Refractive error: sphere -0.5 D, cylinder -2 D, axis 100°. Captured on a Topcon TRC-NW400 fundus camera. 2212x1661px. Patient age: 89 years. Axial length: 24.33 mm. Optic disc at the center of the field. Pachymetry 575 µm:
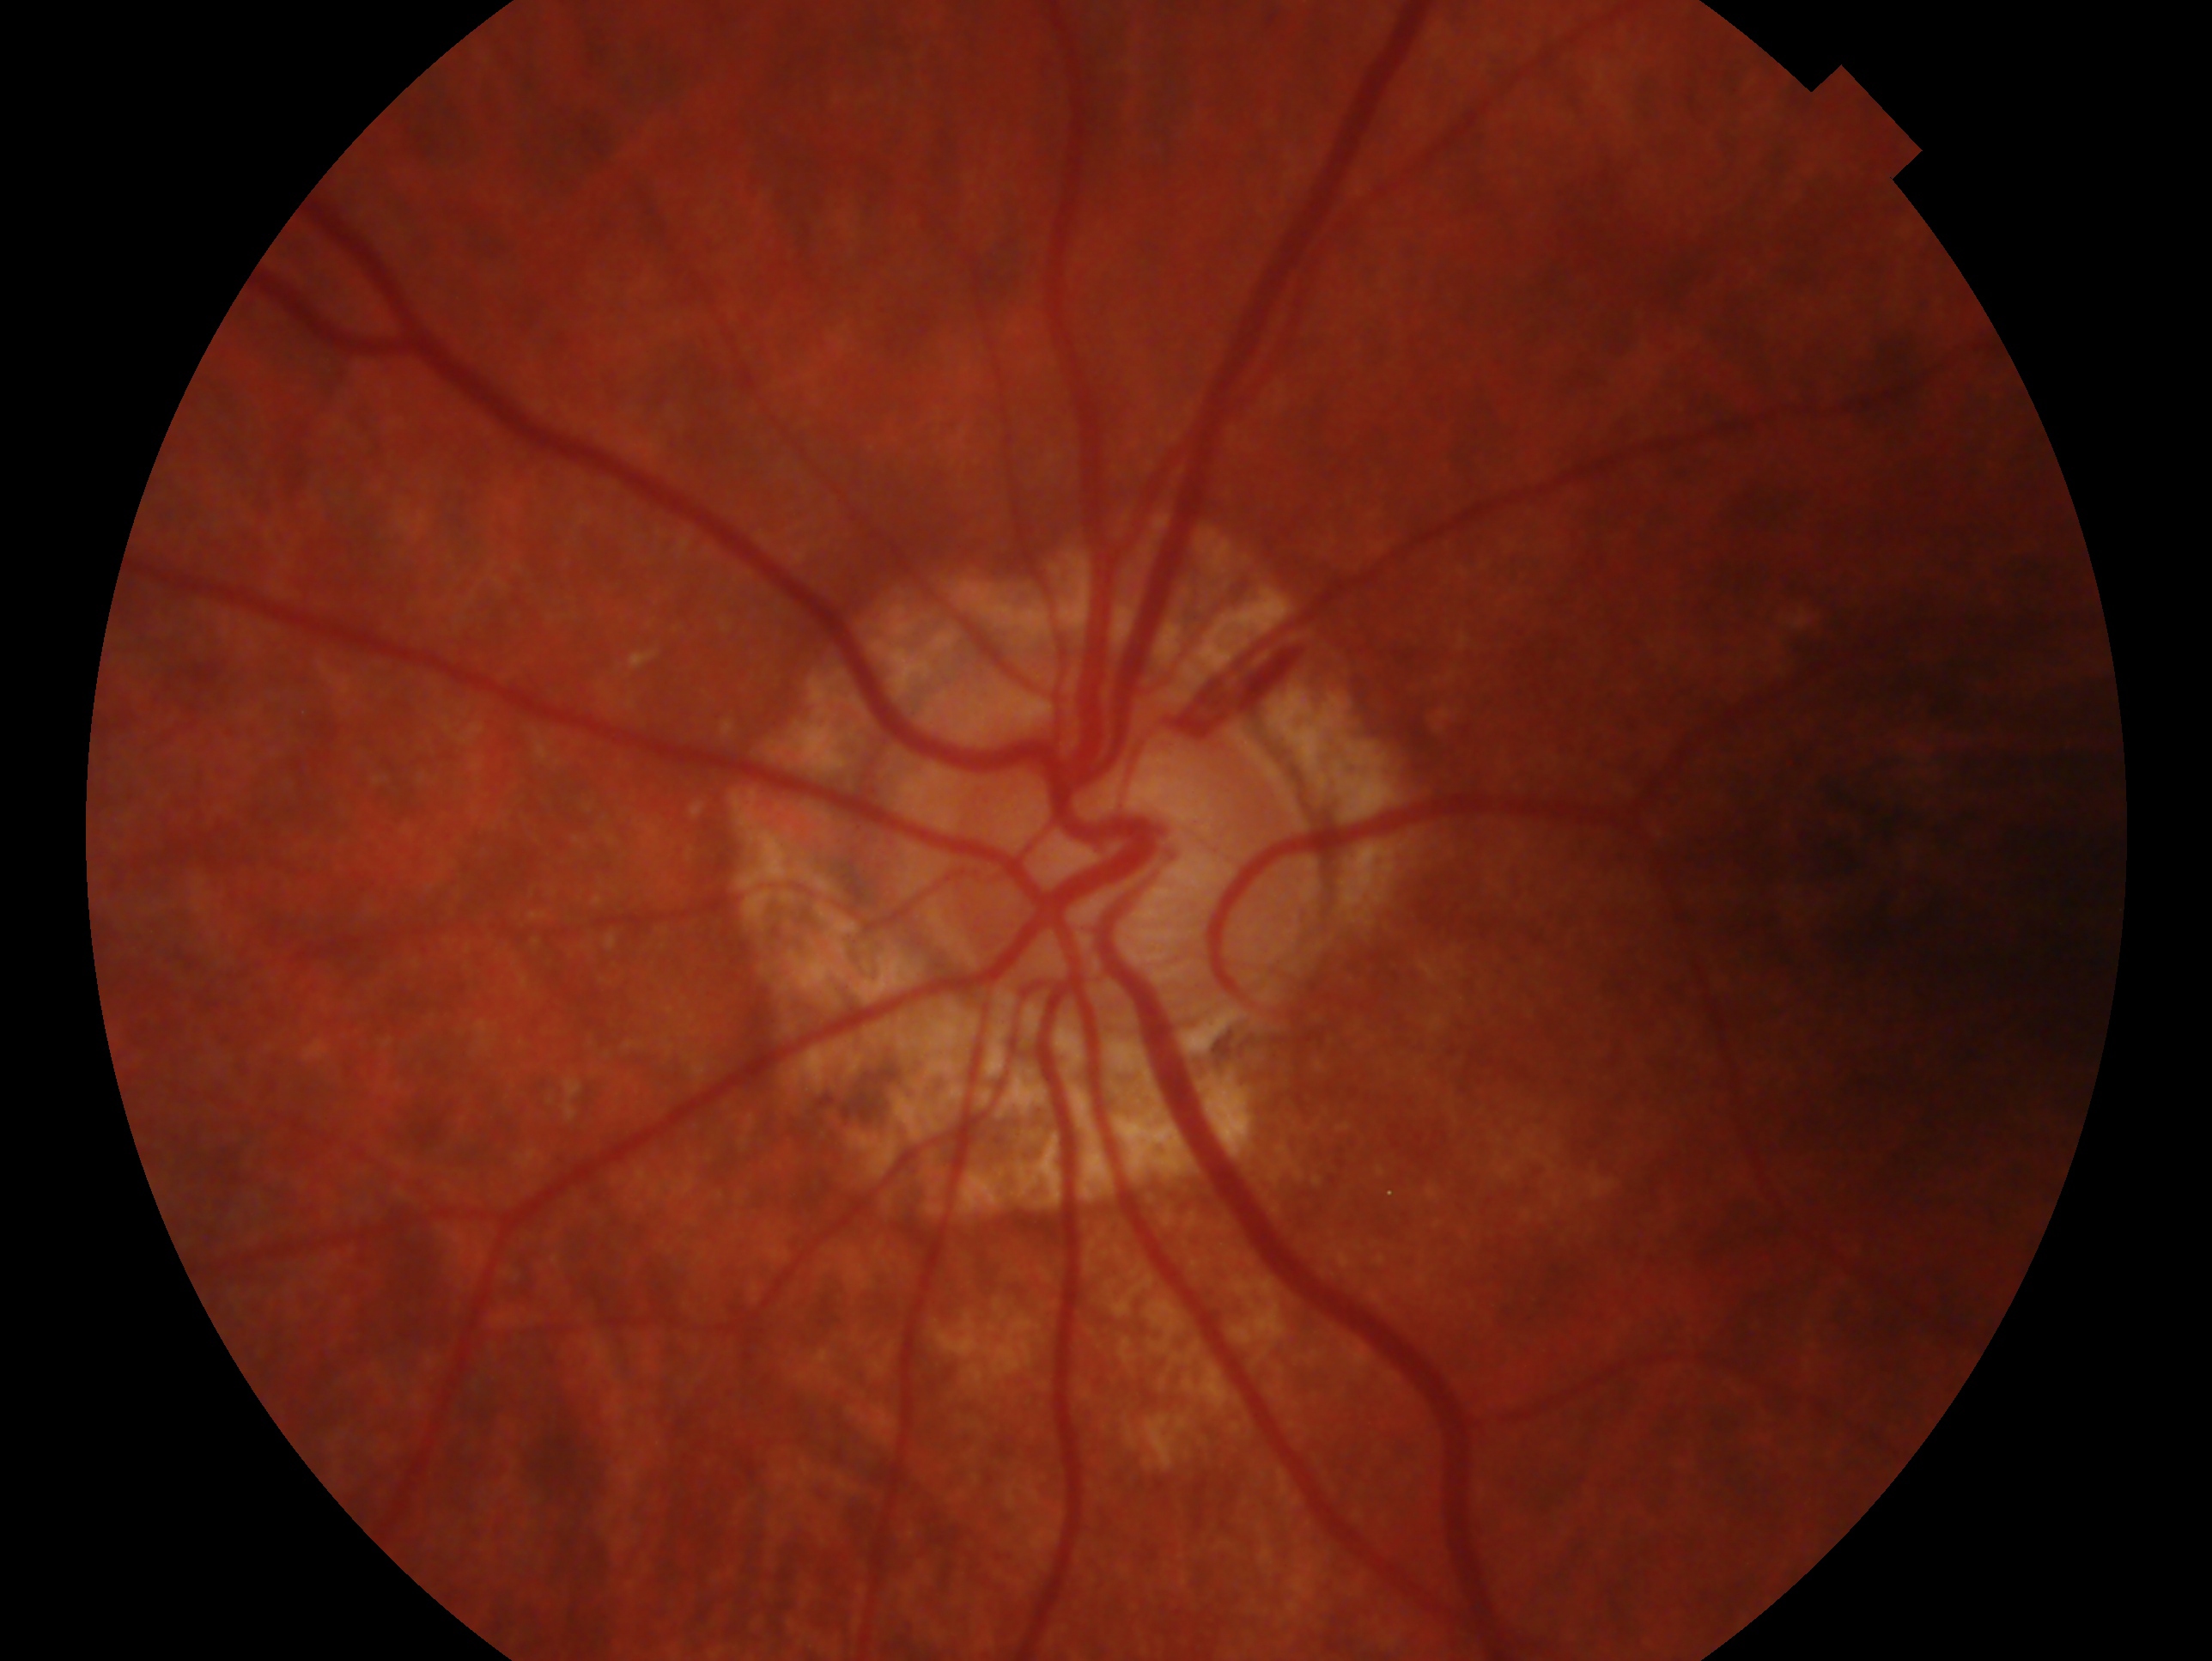
Assessment: glaucomatous — clinically confirmed glaucoma with characteristic optic nerve damage.
This is the oculus sinister.